Macula at the center of the field: 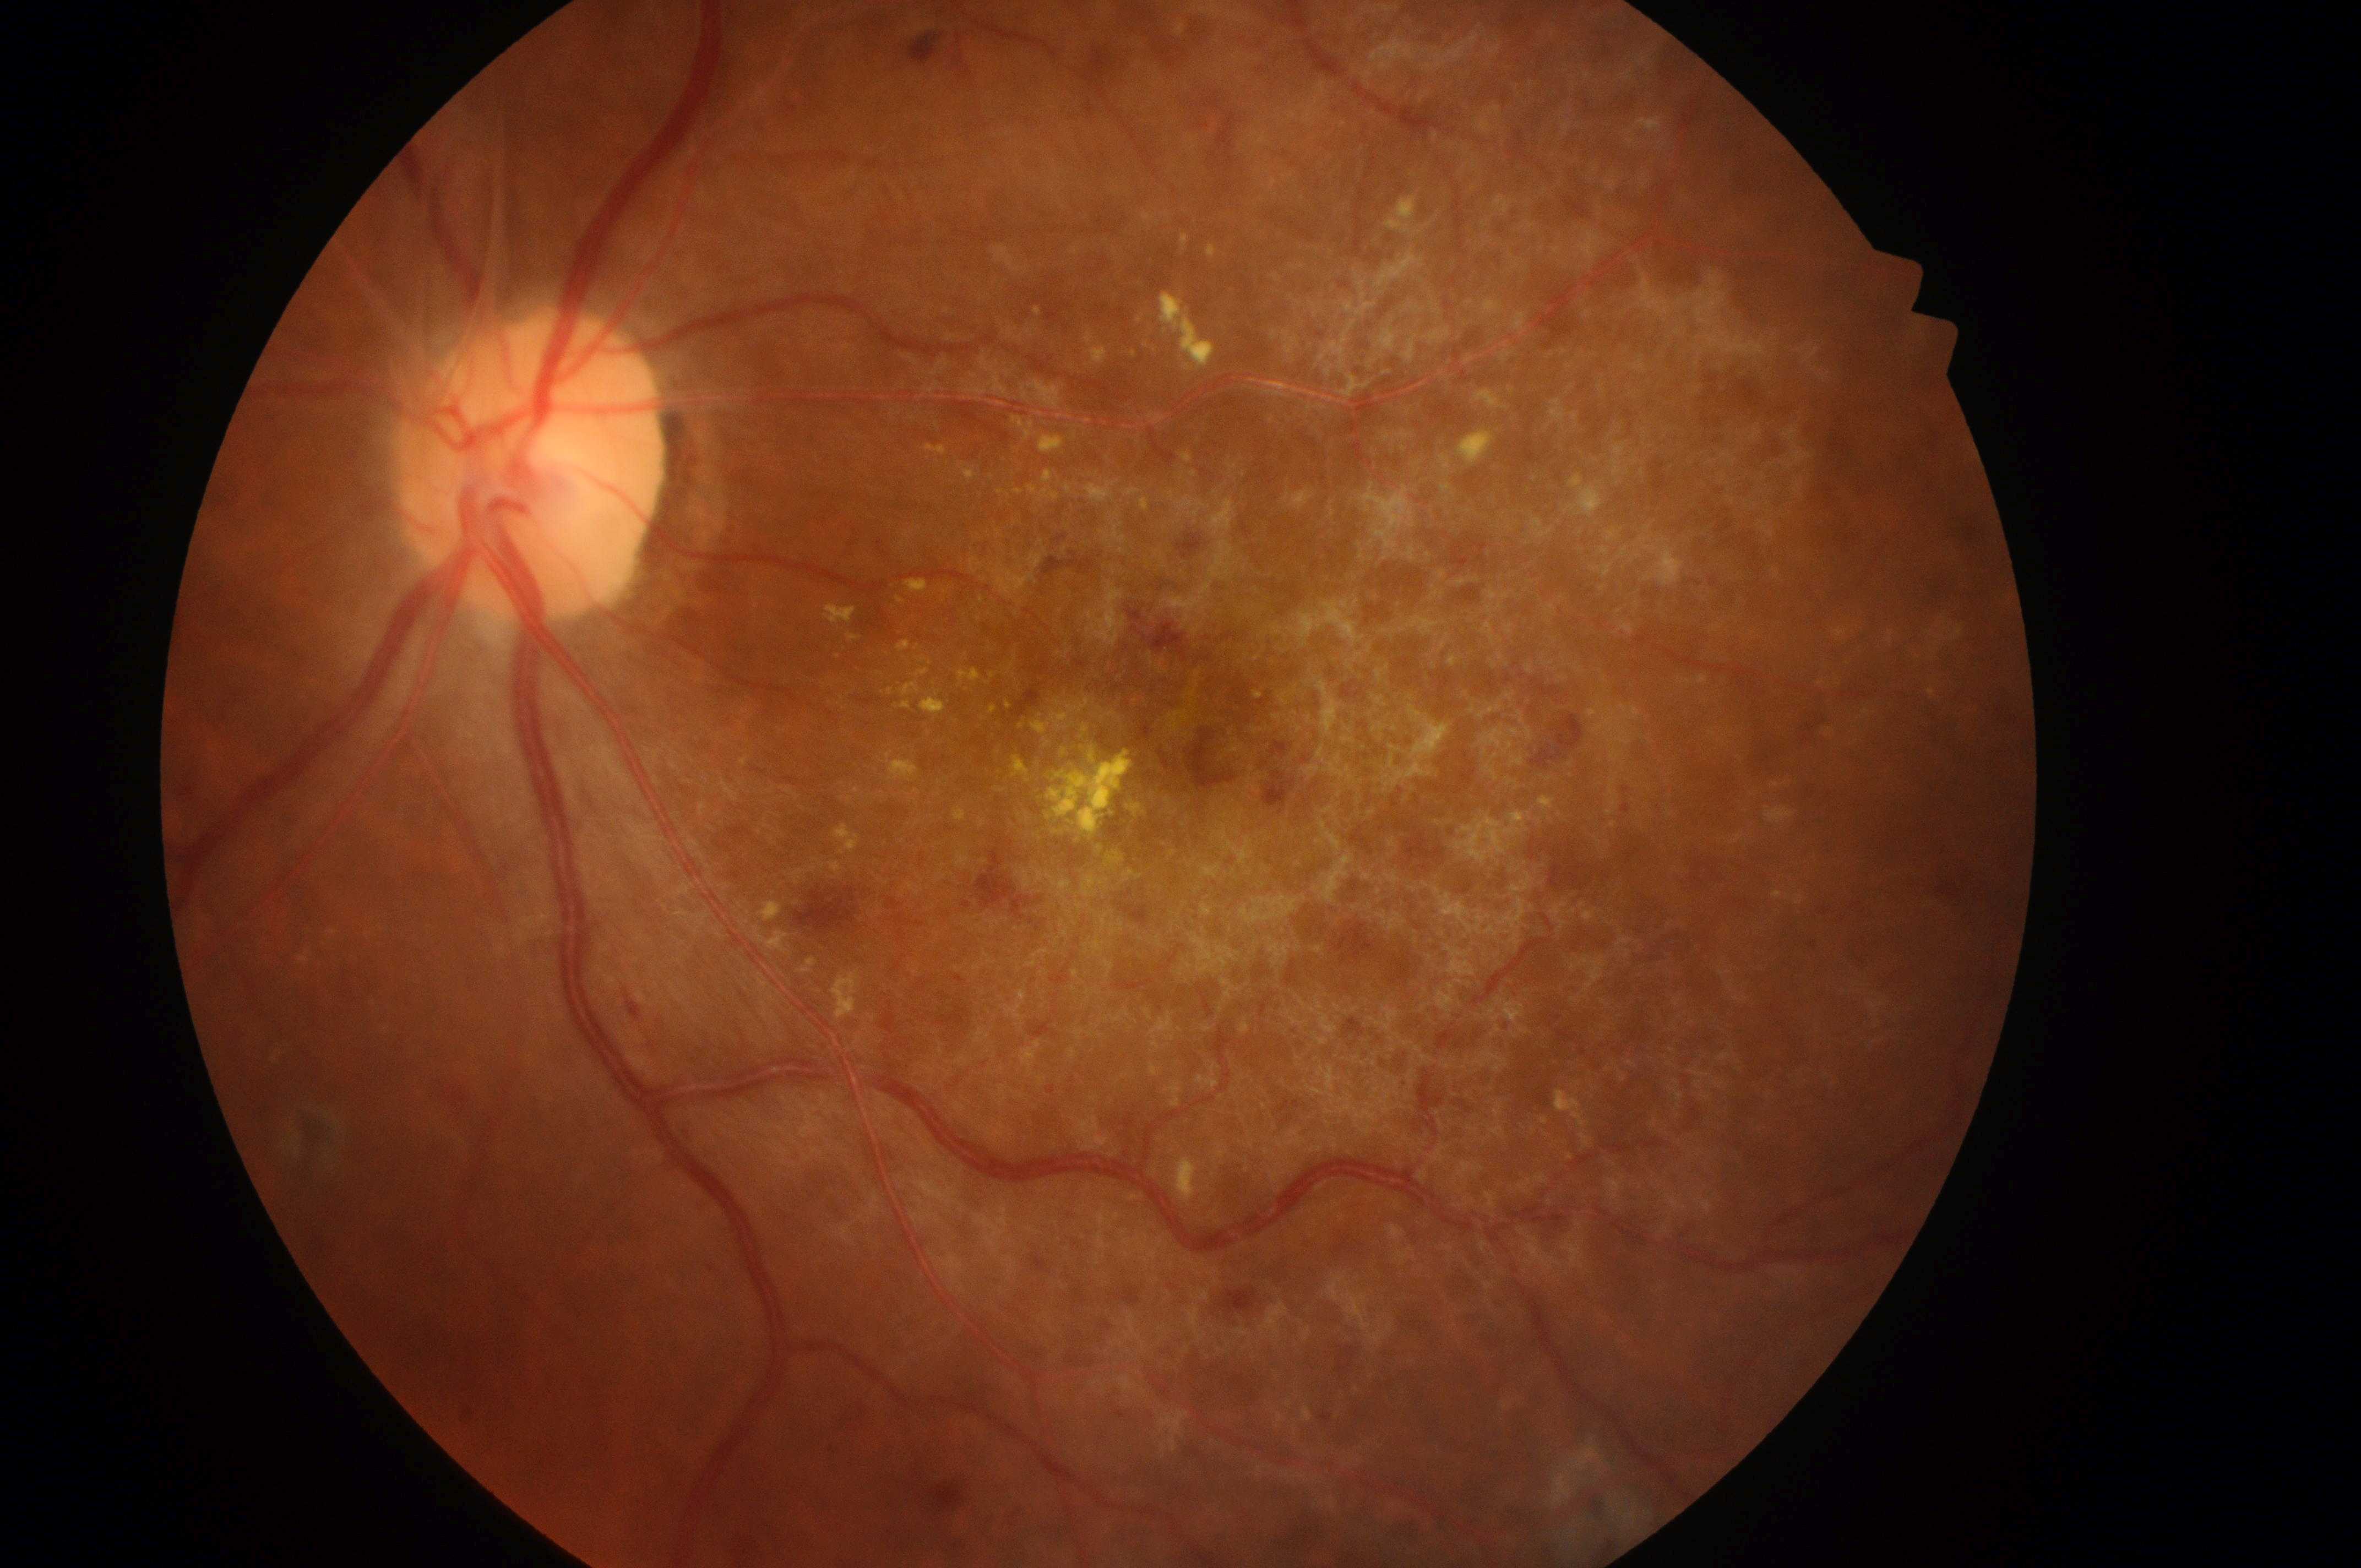

Findings:
• macular center: [1209, 723]
• eye: OS
• optic disc center: [519, 472]
• diabetic retinopathy severity: grade 4
• diabetic macular edema: 2/2